Retinal fundus photograph. Modified Davis grading. Nonmydriatic — 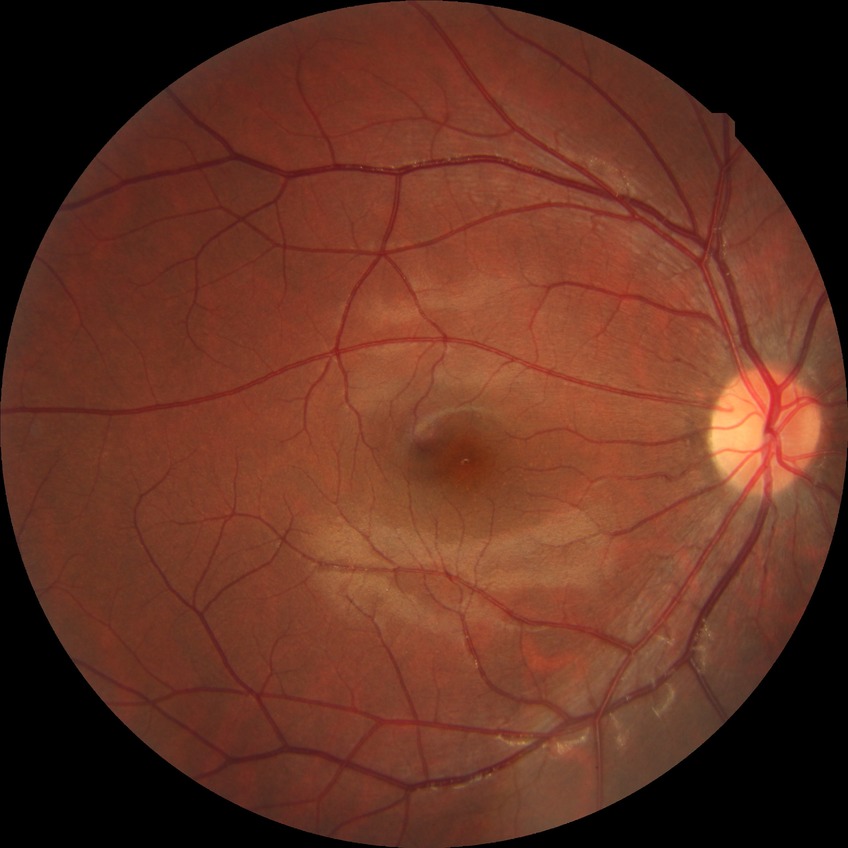
retinopathy stage: no diabetic retinopathy